NIDEK AFC-230. Retinal fundus photograph.
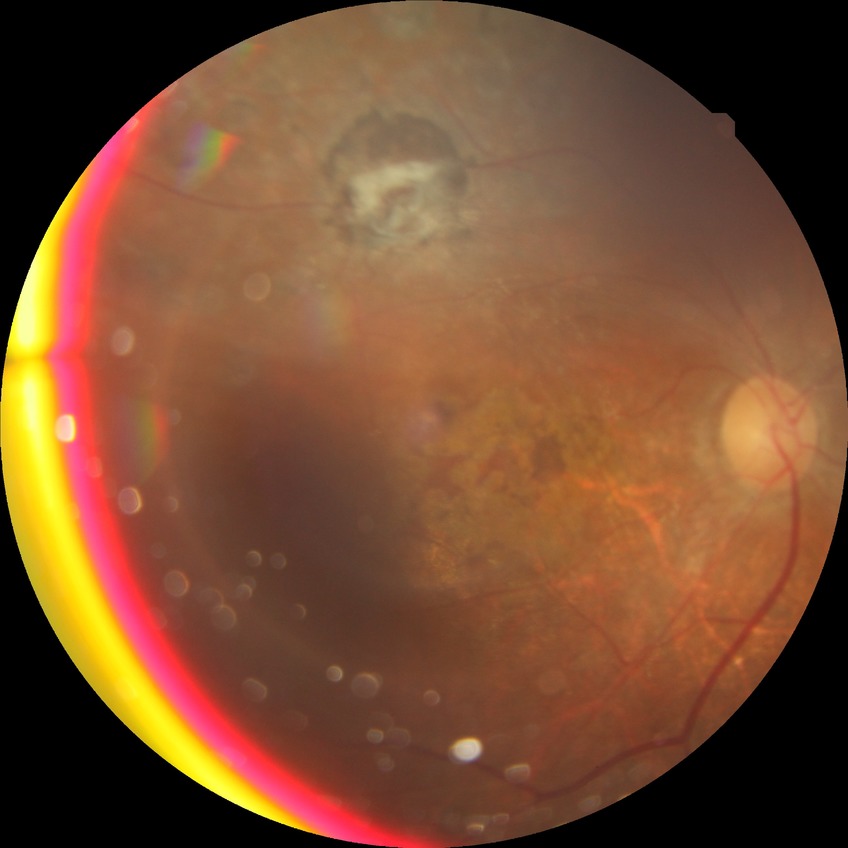
Diabetic retinopathy grade: proliferative diabetic retinopathy.